848x848px. Graded on the modified Davis scale. Nonmydriatic. 45 degree fundus photograph.
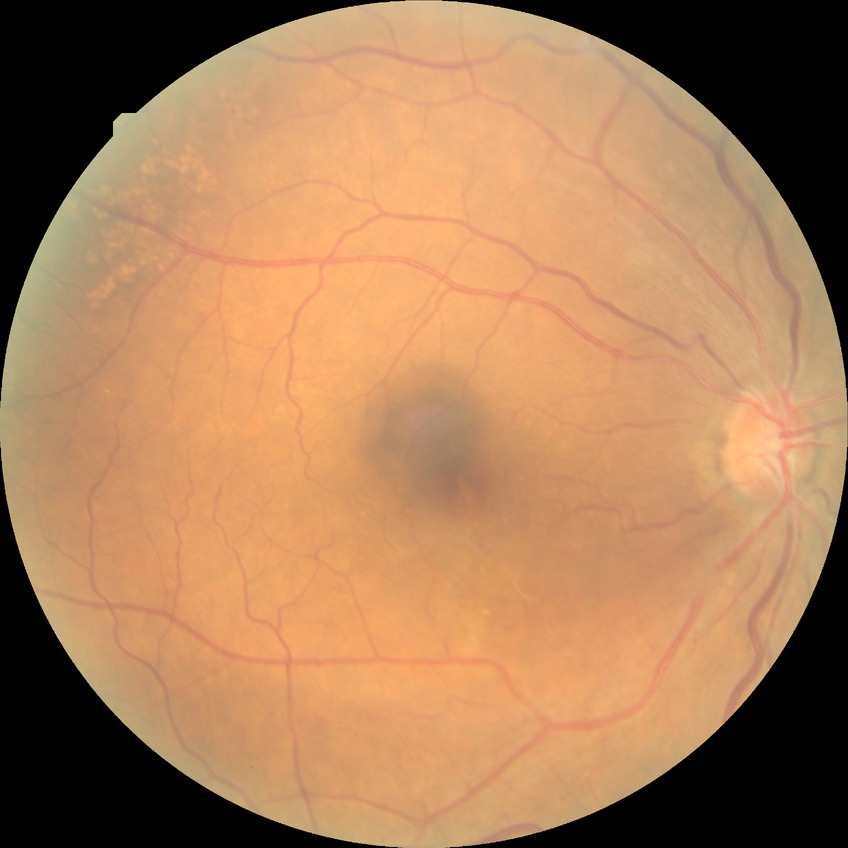
retinopathy stage: no diabetic retinopathy.